No pharmacologic dilation — 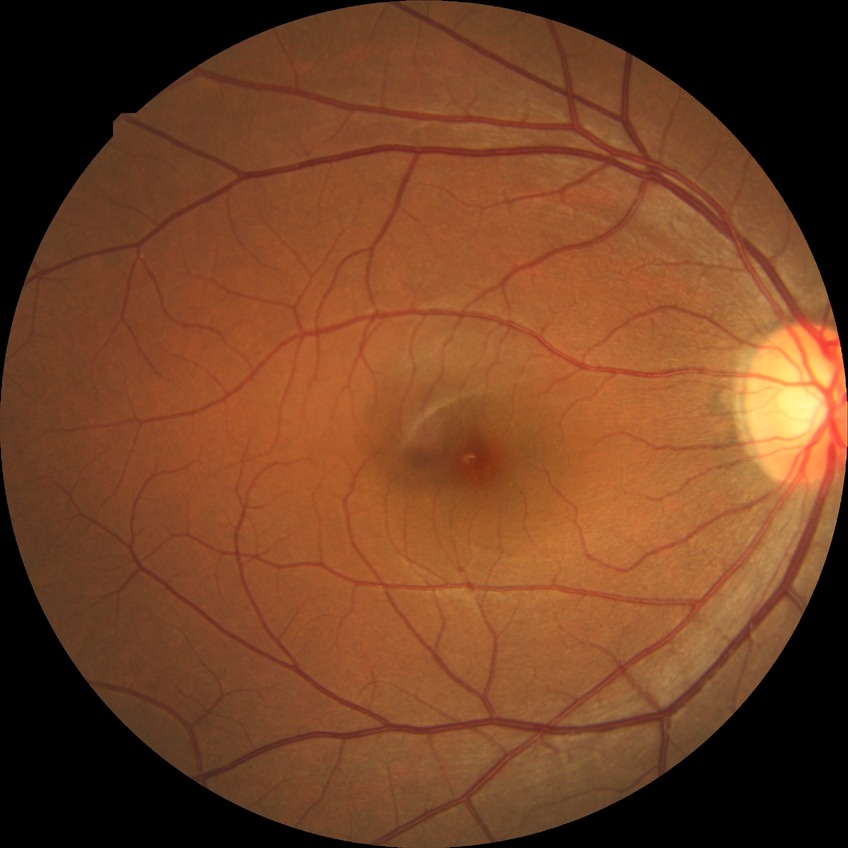

davis_grade: no diabetic retinopathy